848x848px · NIDEK AFC-230 fundus camera · without pupil dilation · 45-degree field of view.
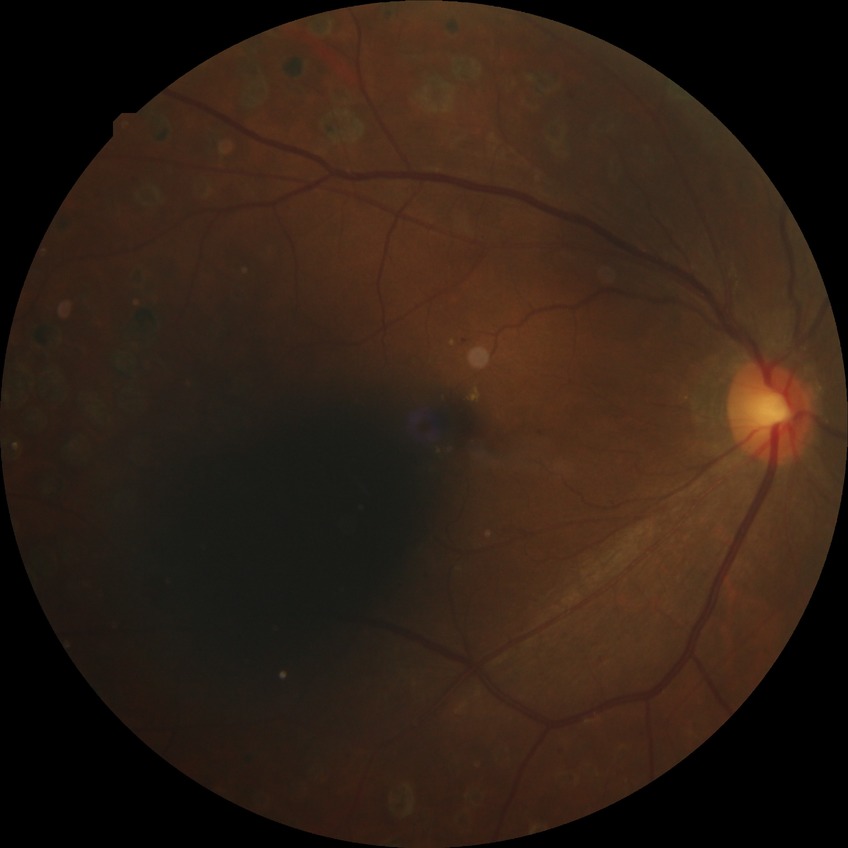
Diabetic retinopathy (DR): proliferative diabetic retinopathy (PDR).